45° field of view; 2352x1568; retinal fundus photograph — 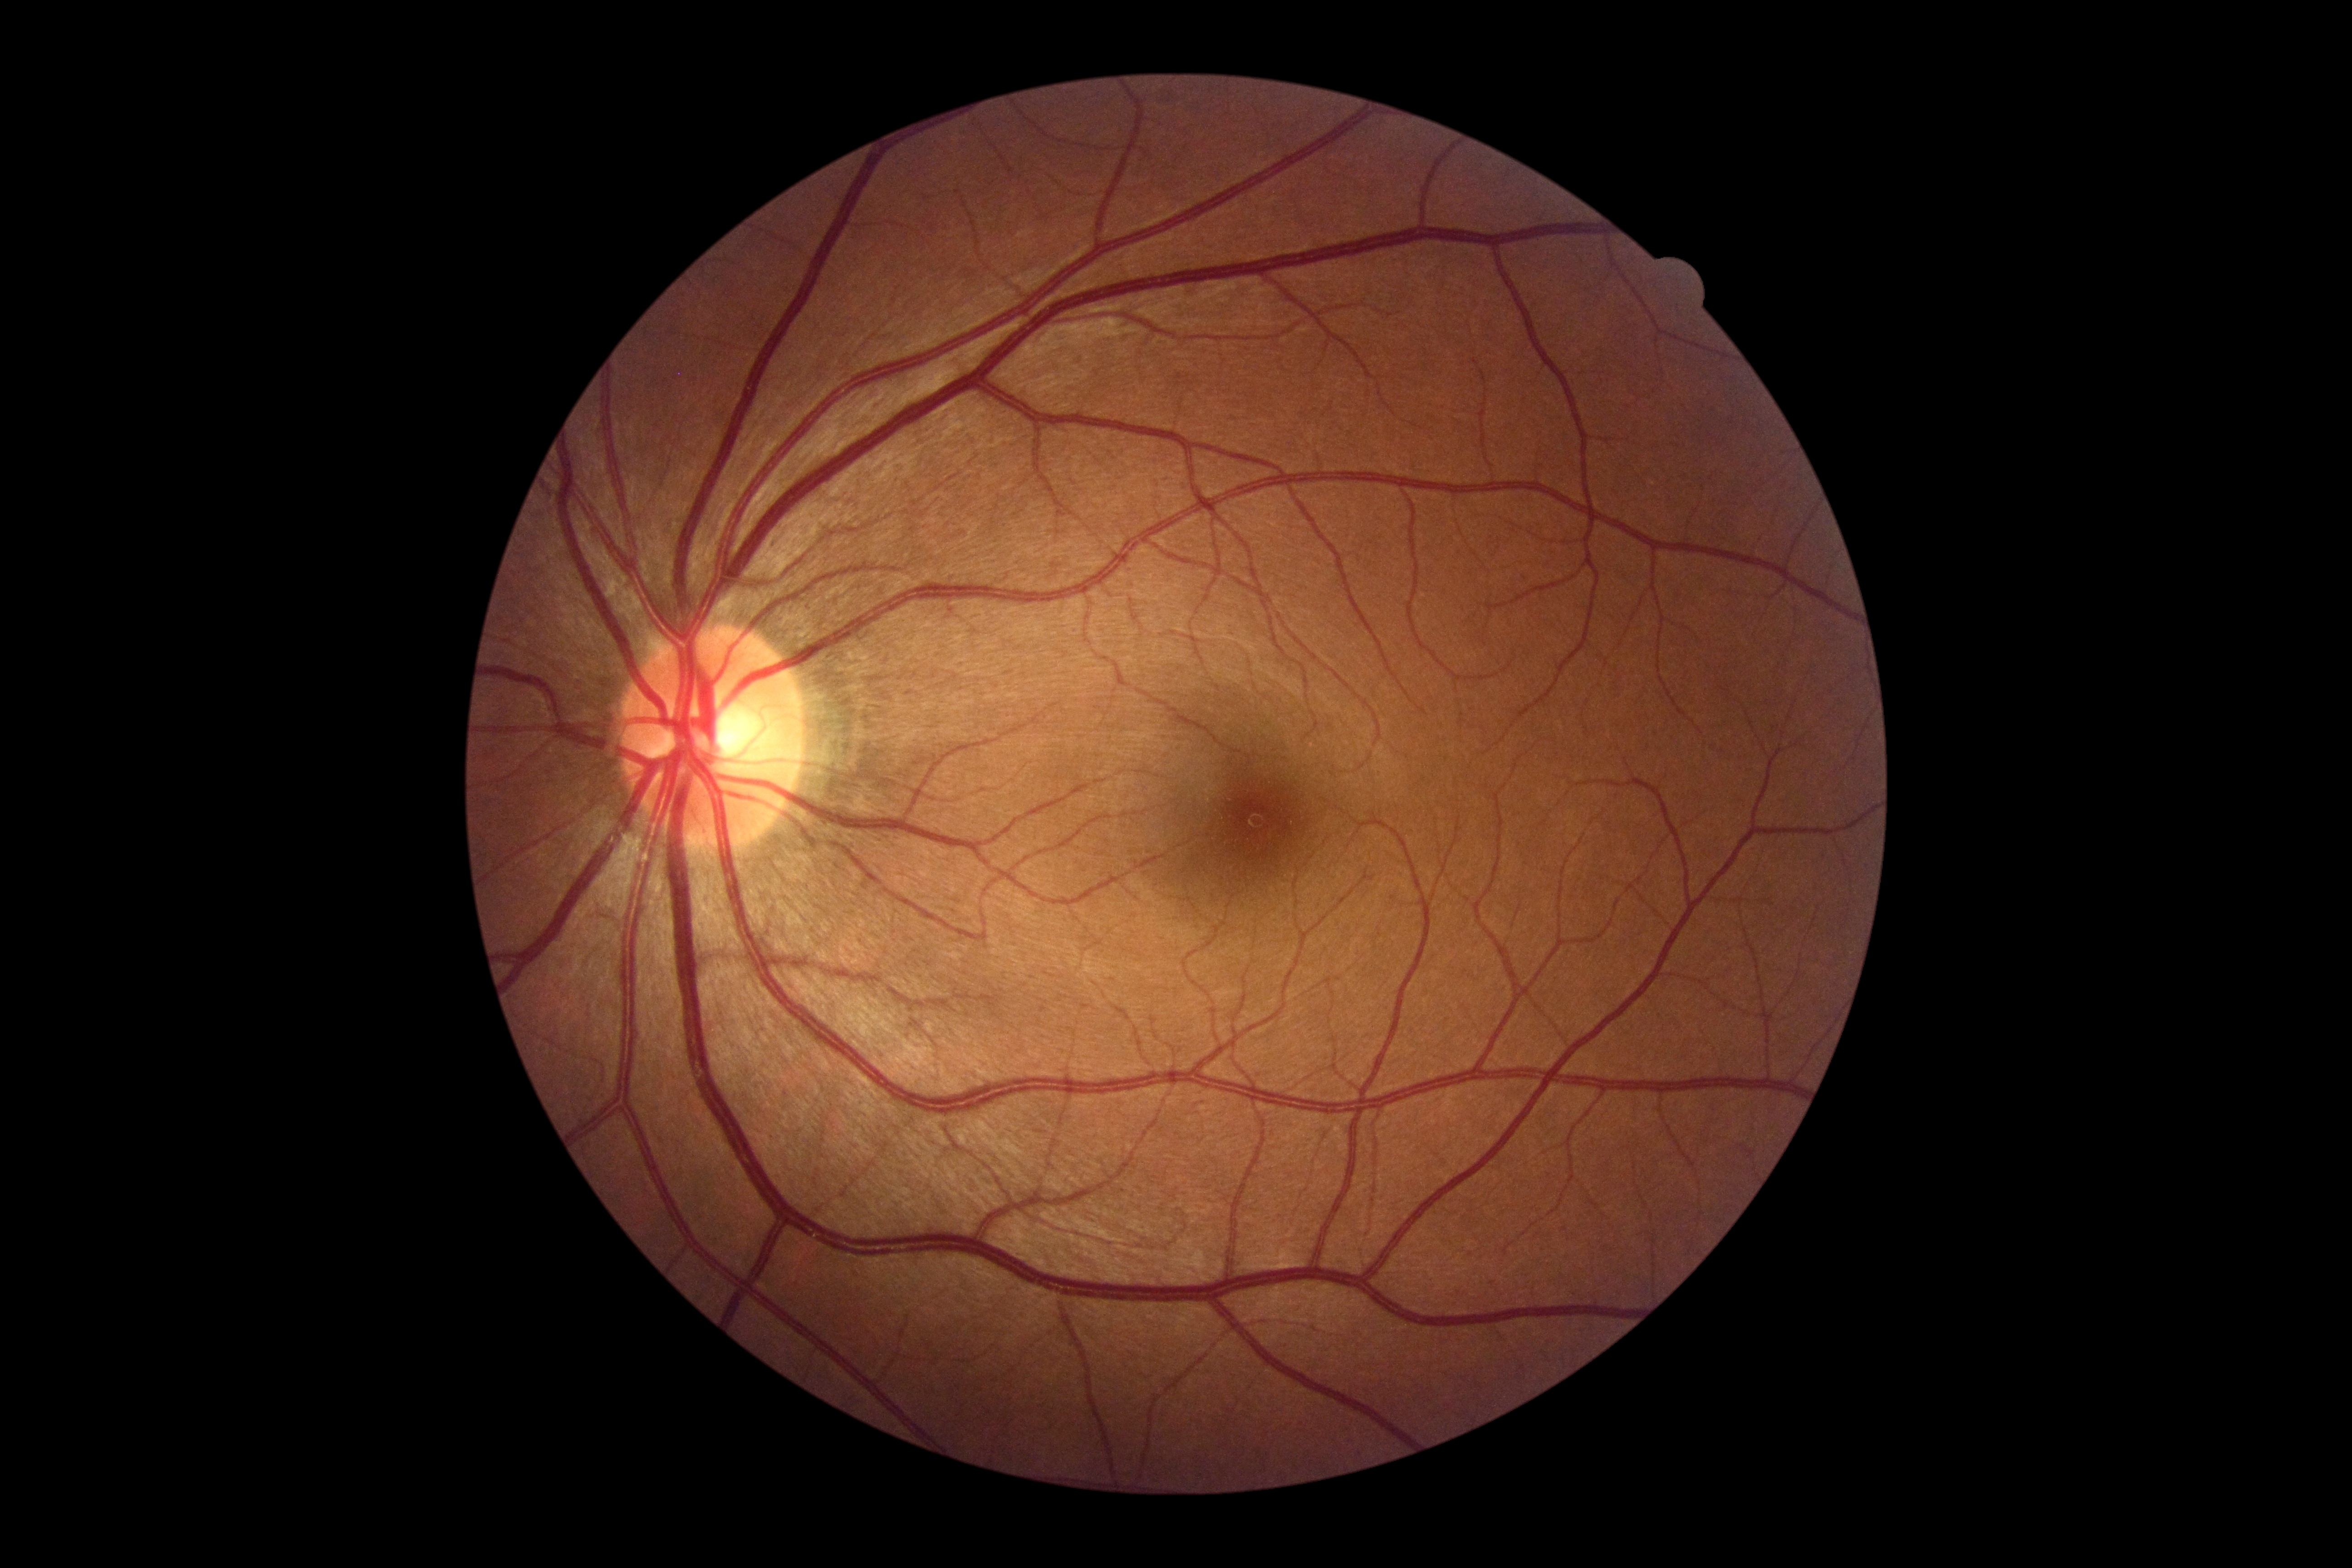

Retinopathy: 0. No diabetic retinal disease findings.